1960x1897:
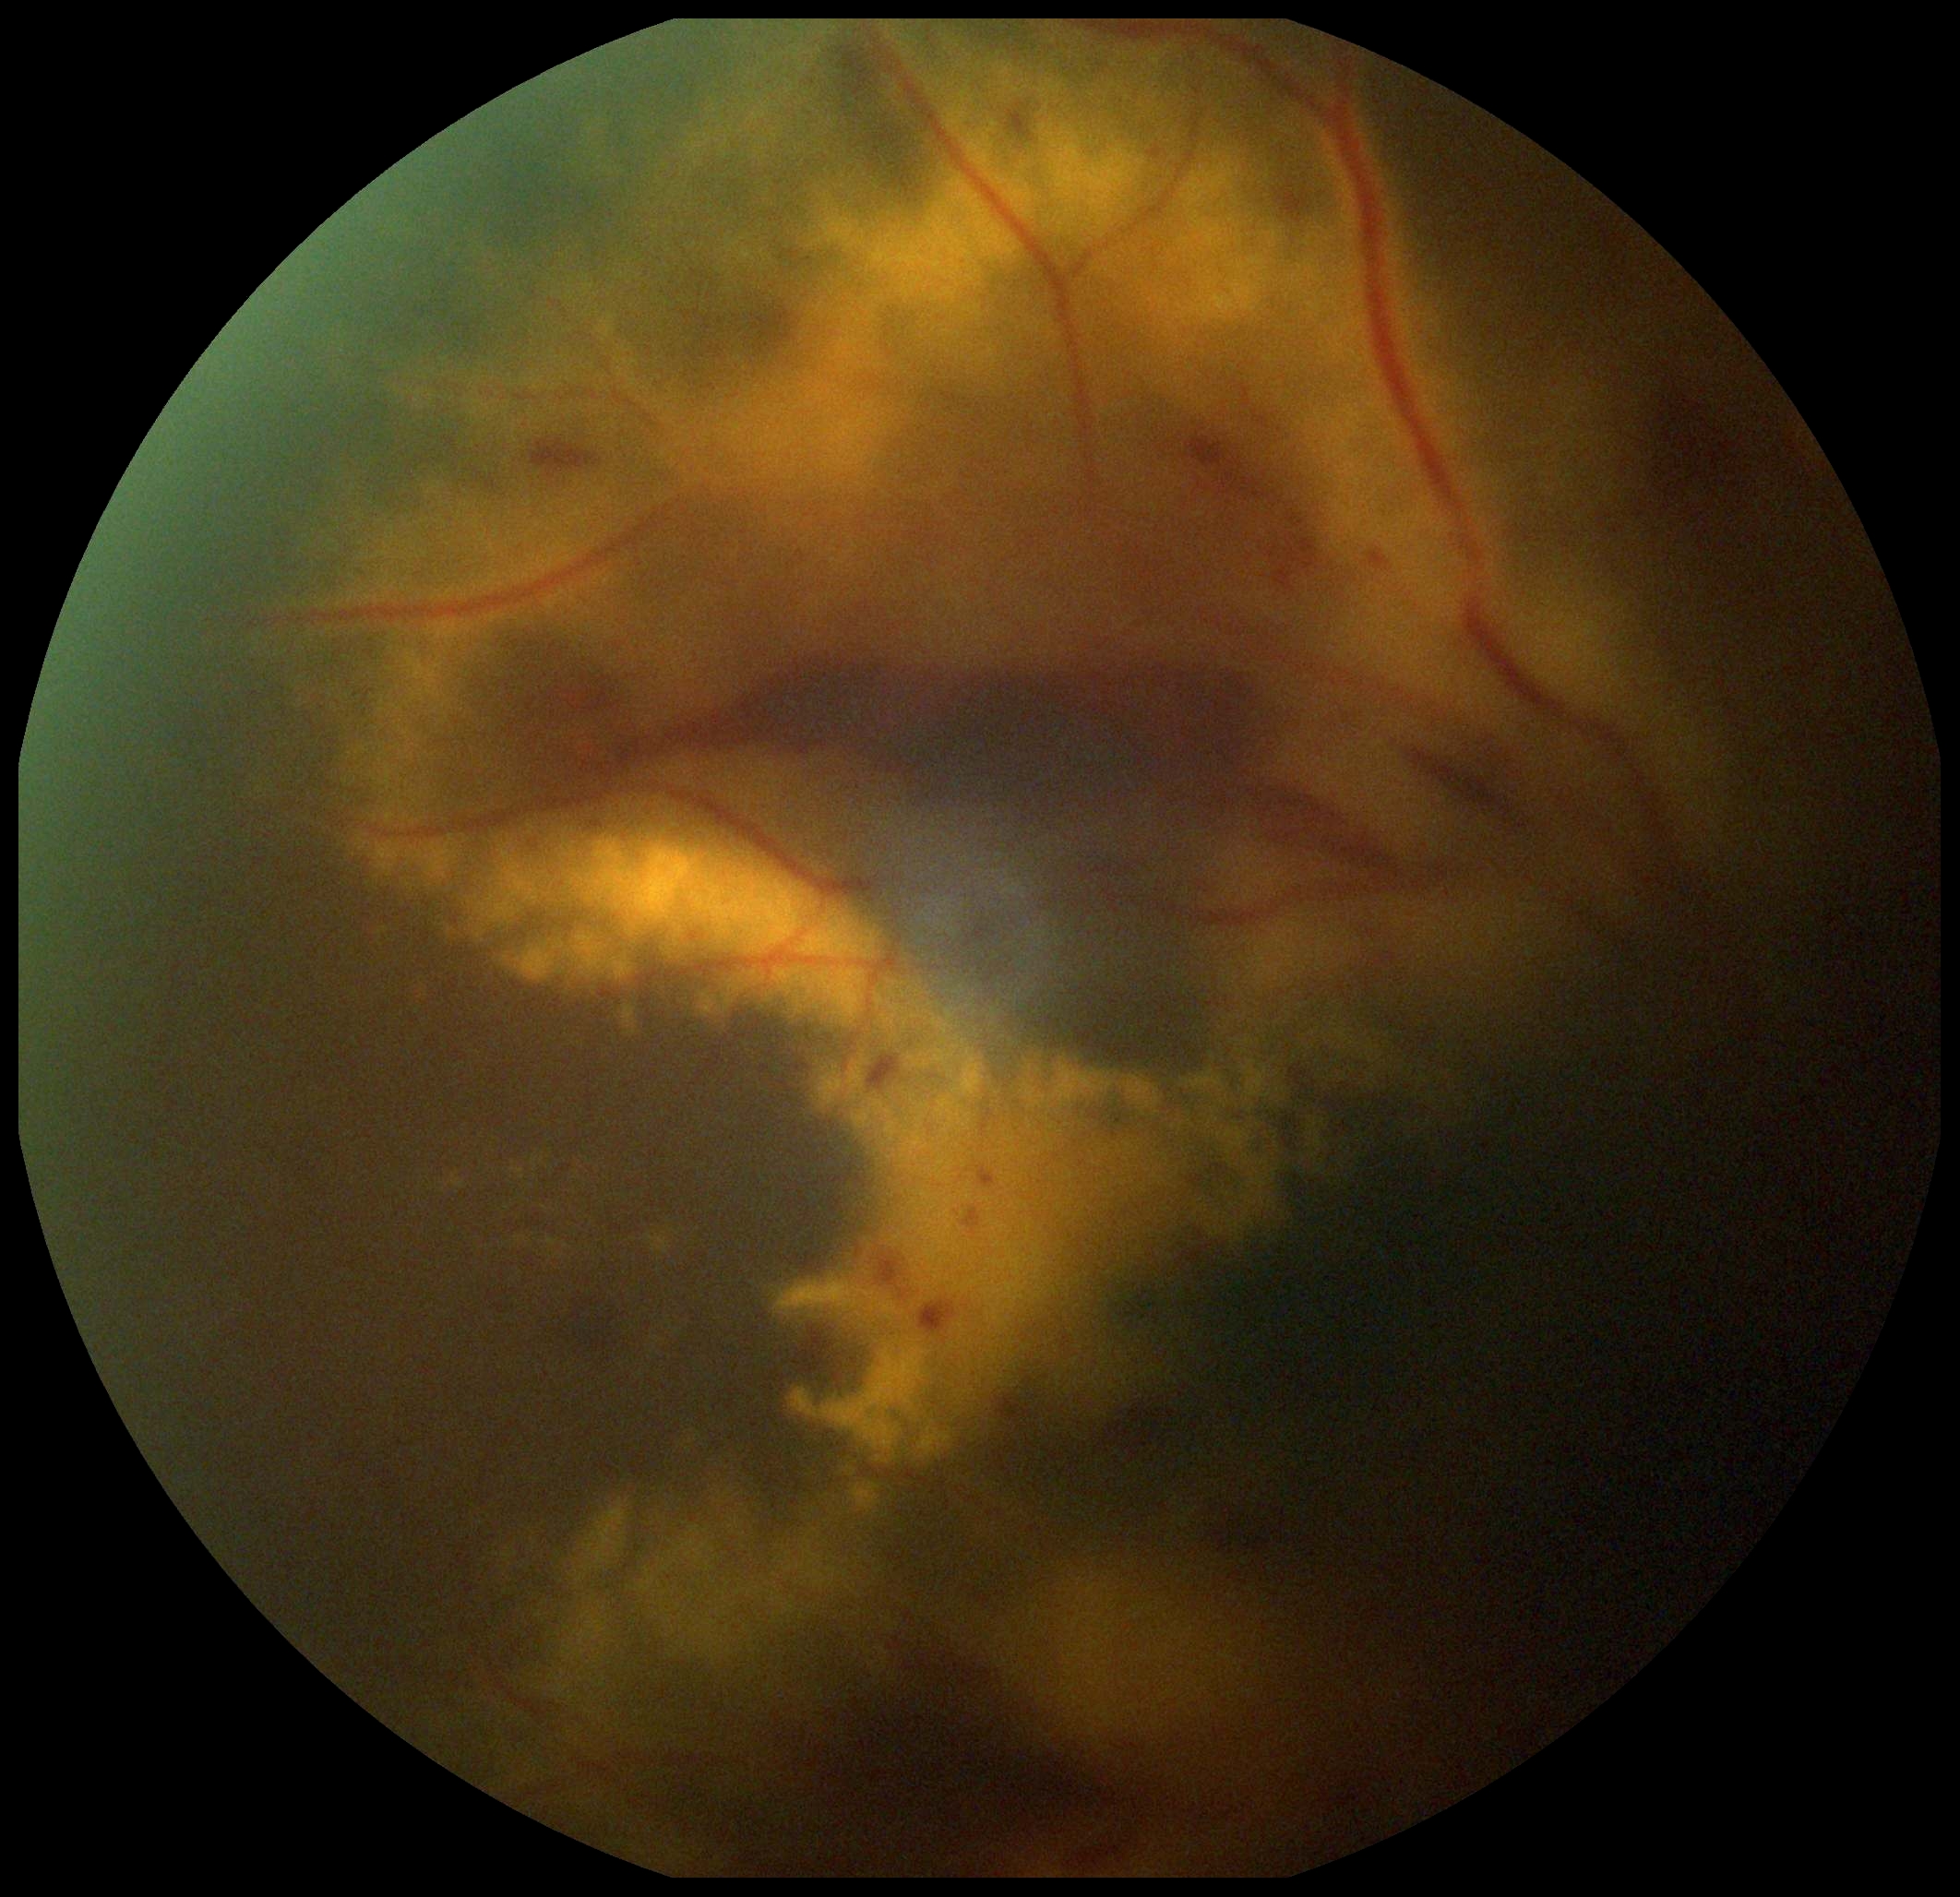 Disease class: proliferative diabetic retinopathy. DR is grade 4 (PDR).